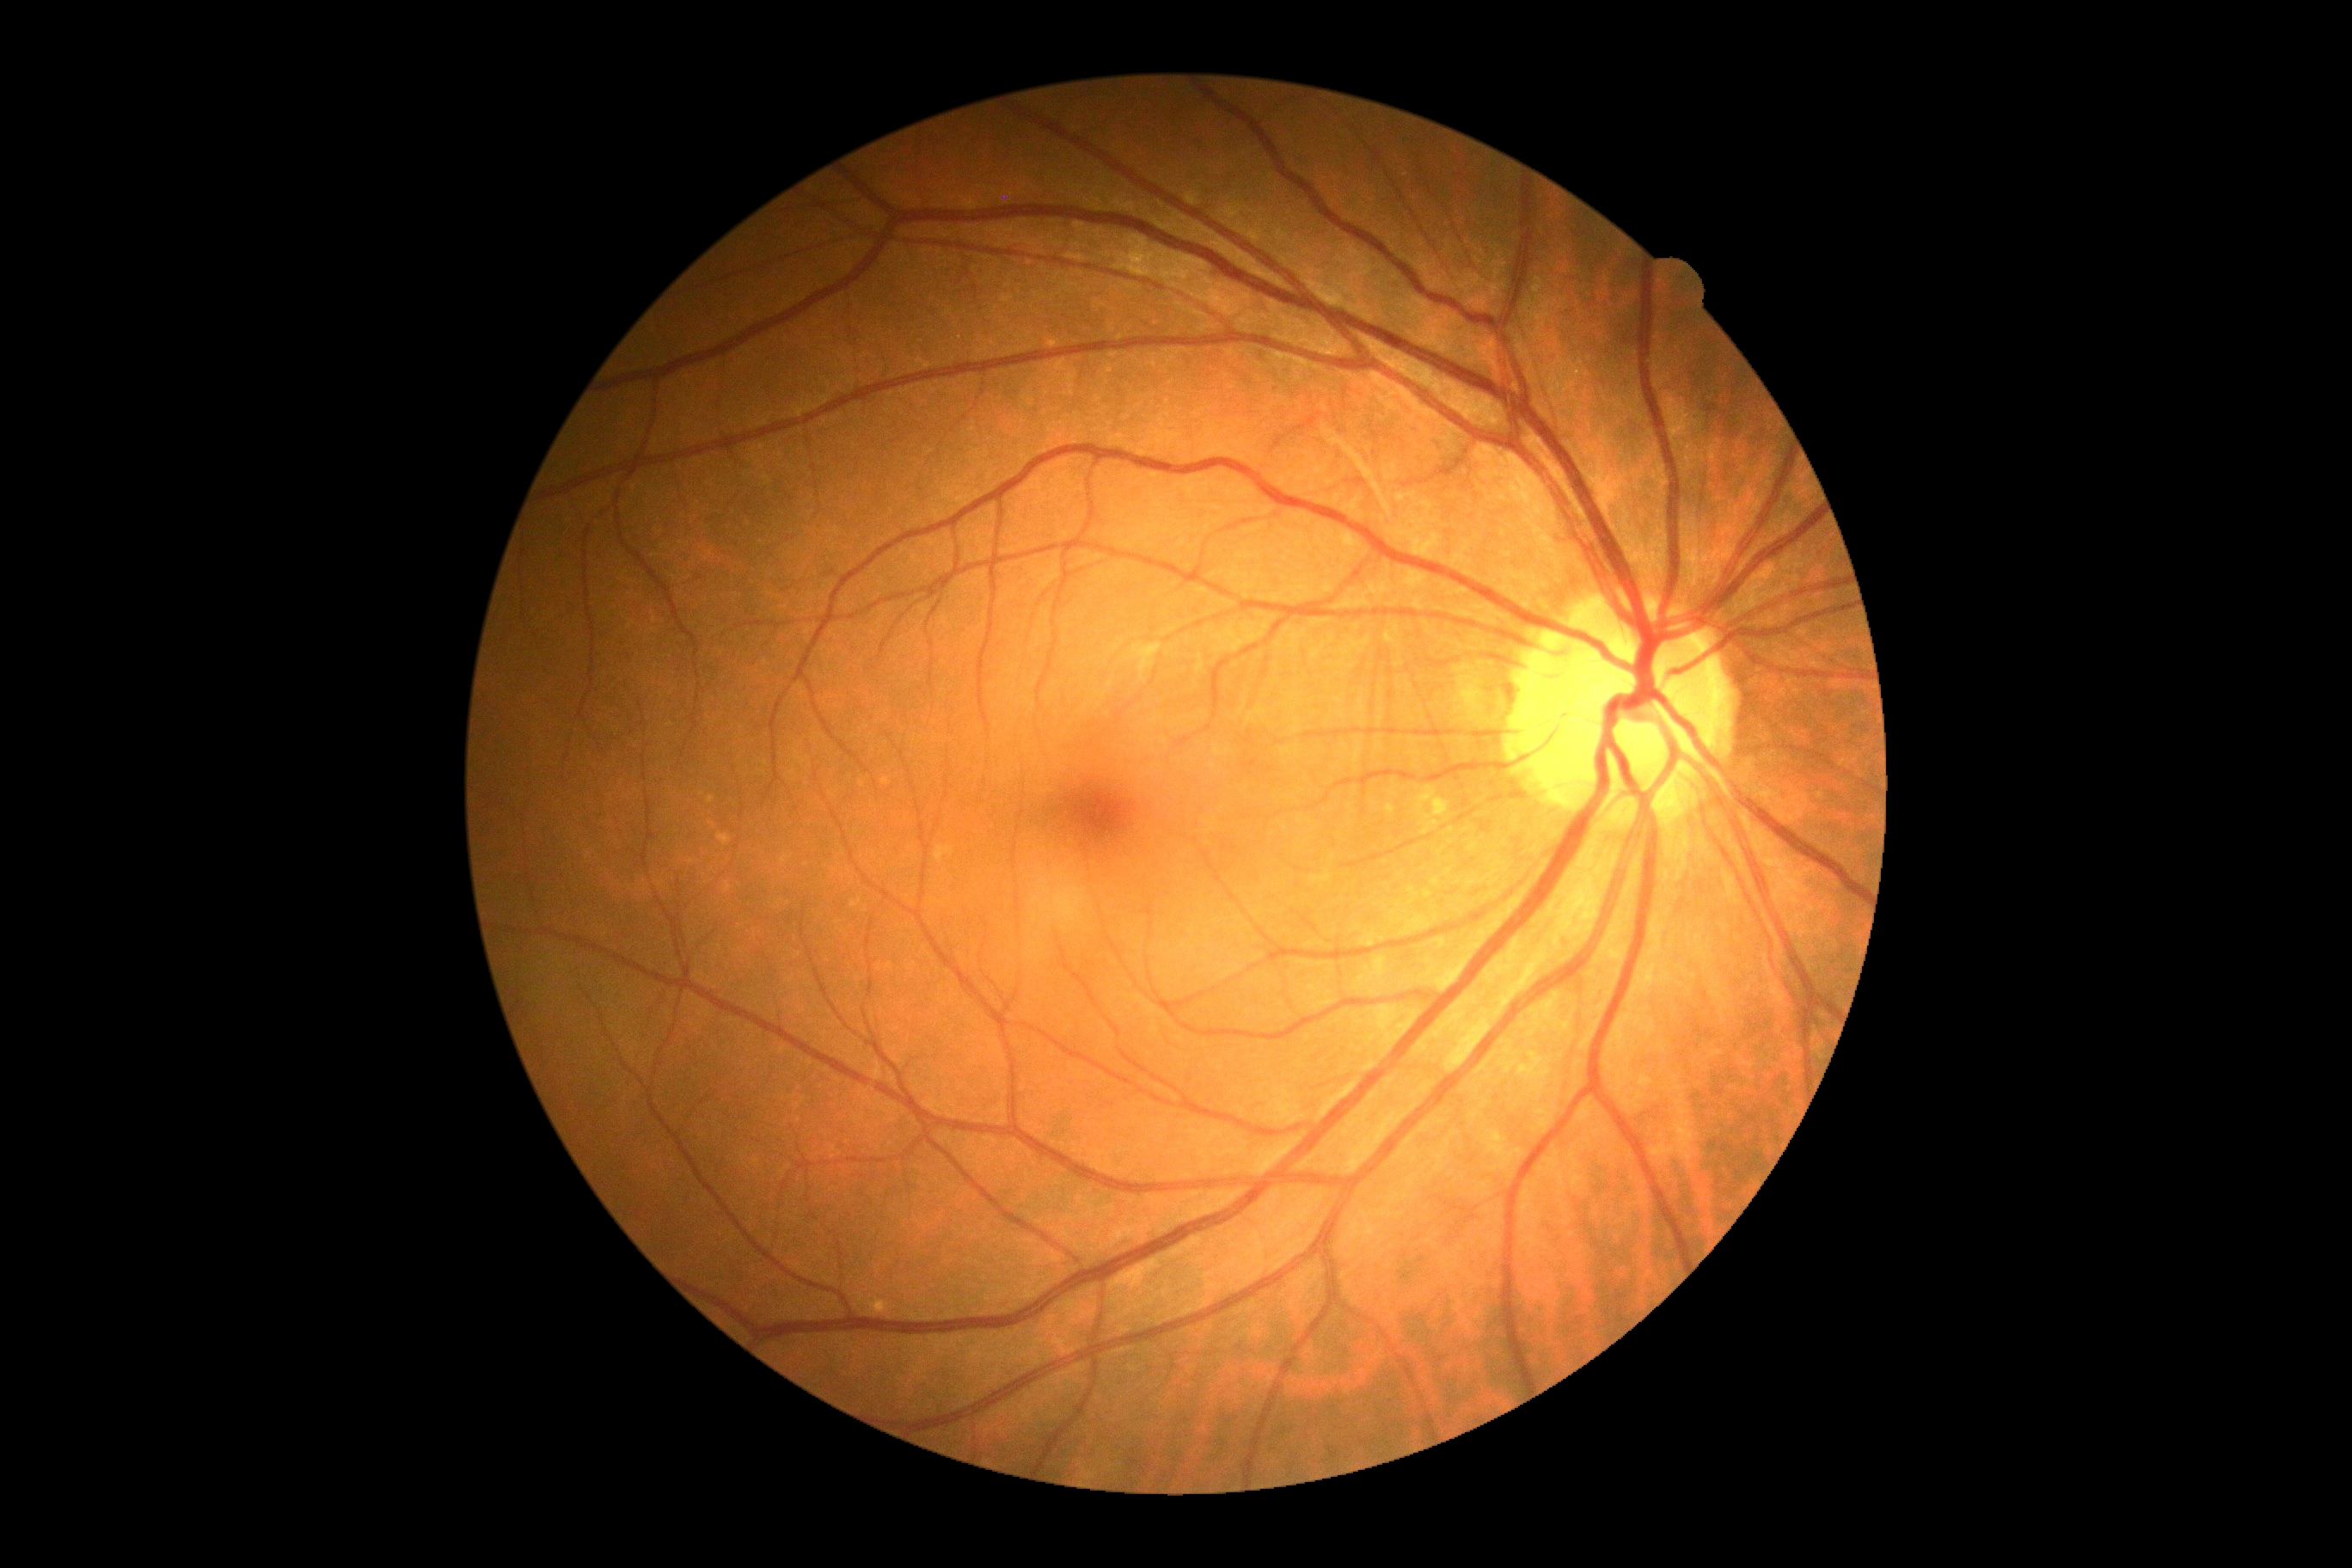

Diabetic retinopathy severity: grade 0.